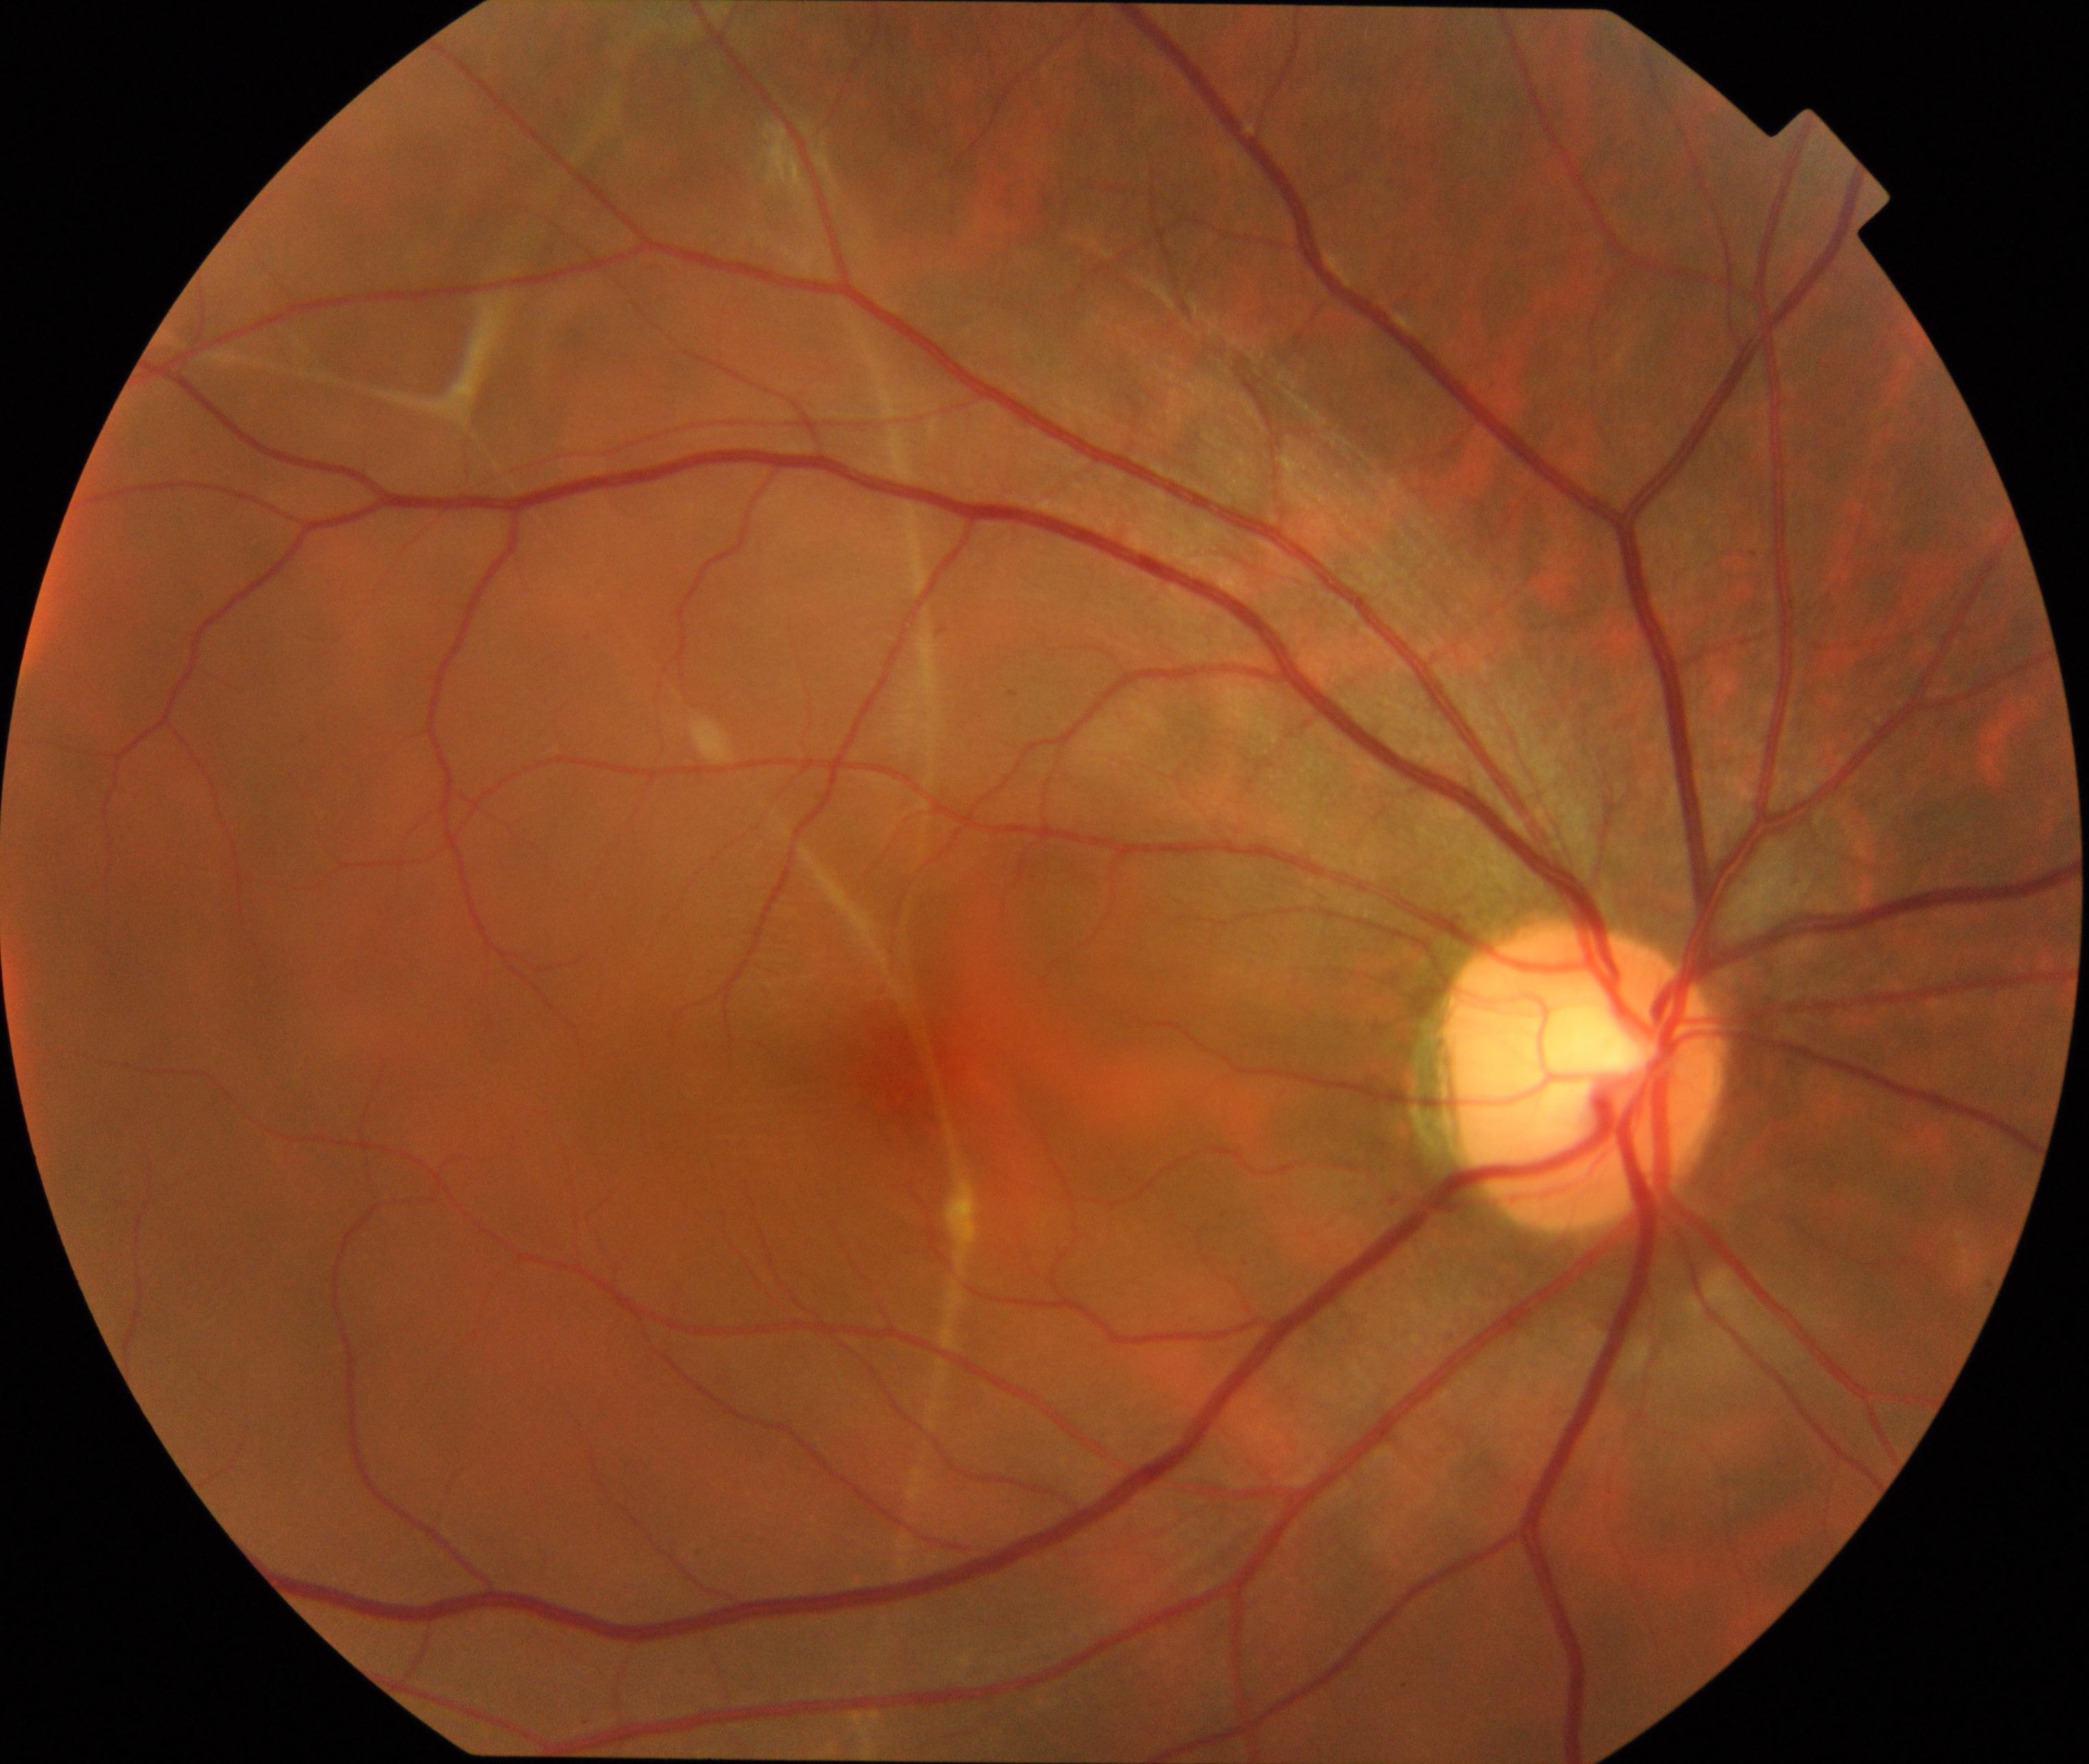
Demonstrates rhegmatogenous retinal detachment. Typically showing slightly opaque, convex or corrugated appearance of elevated retina, sometimes with retinal breaks in view.